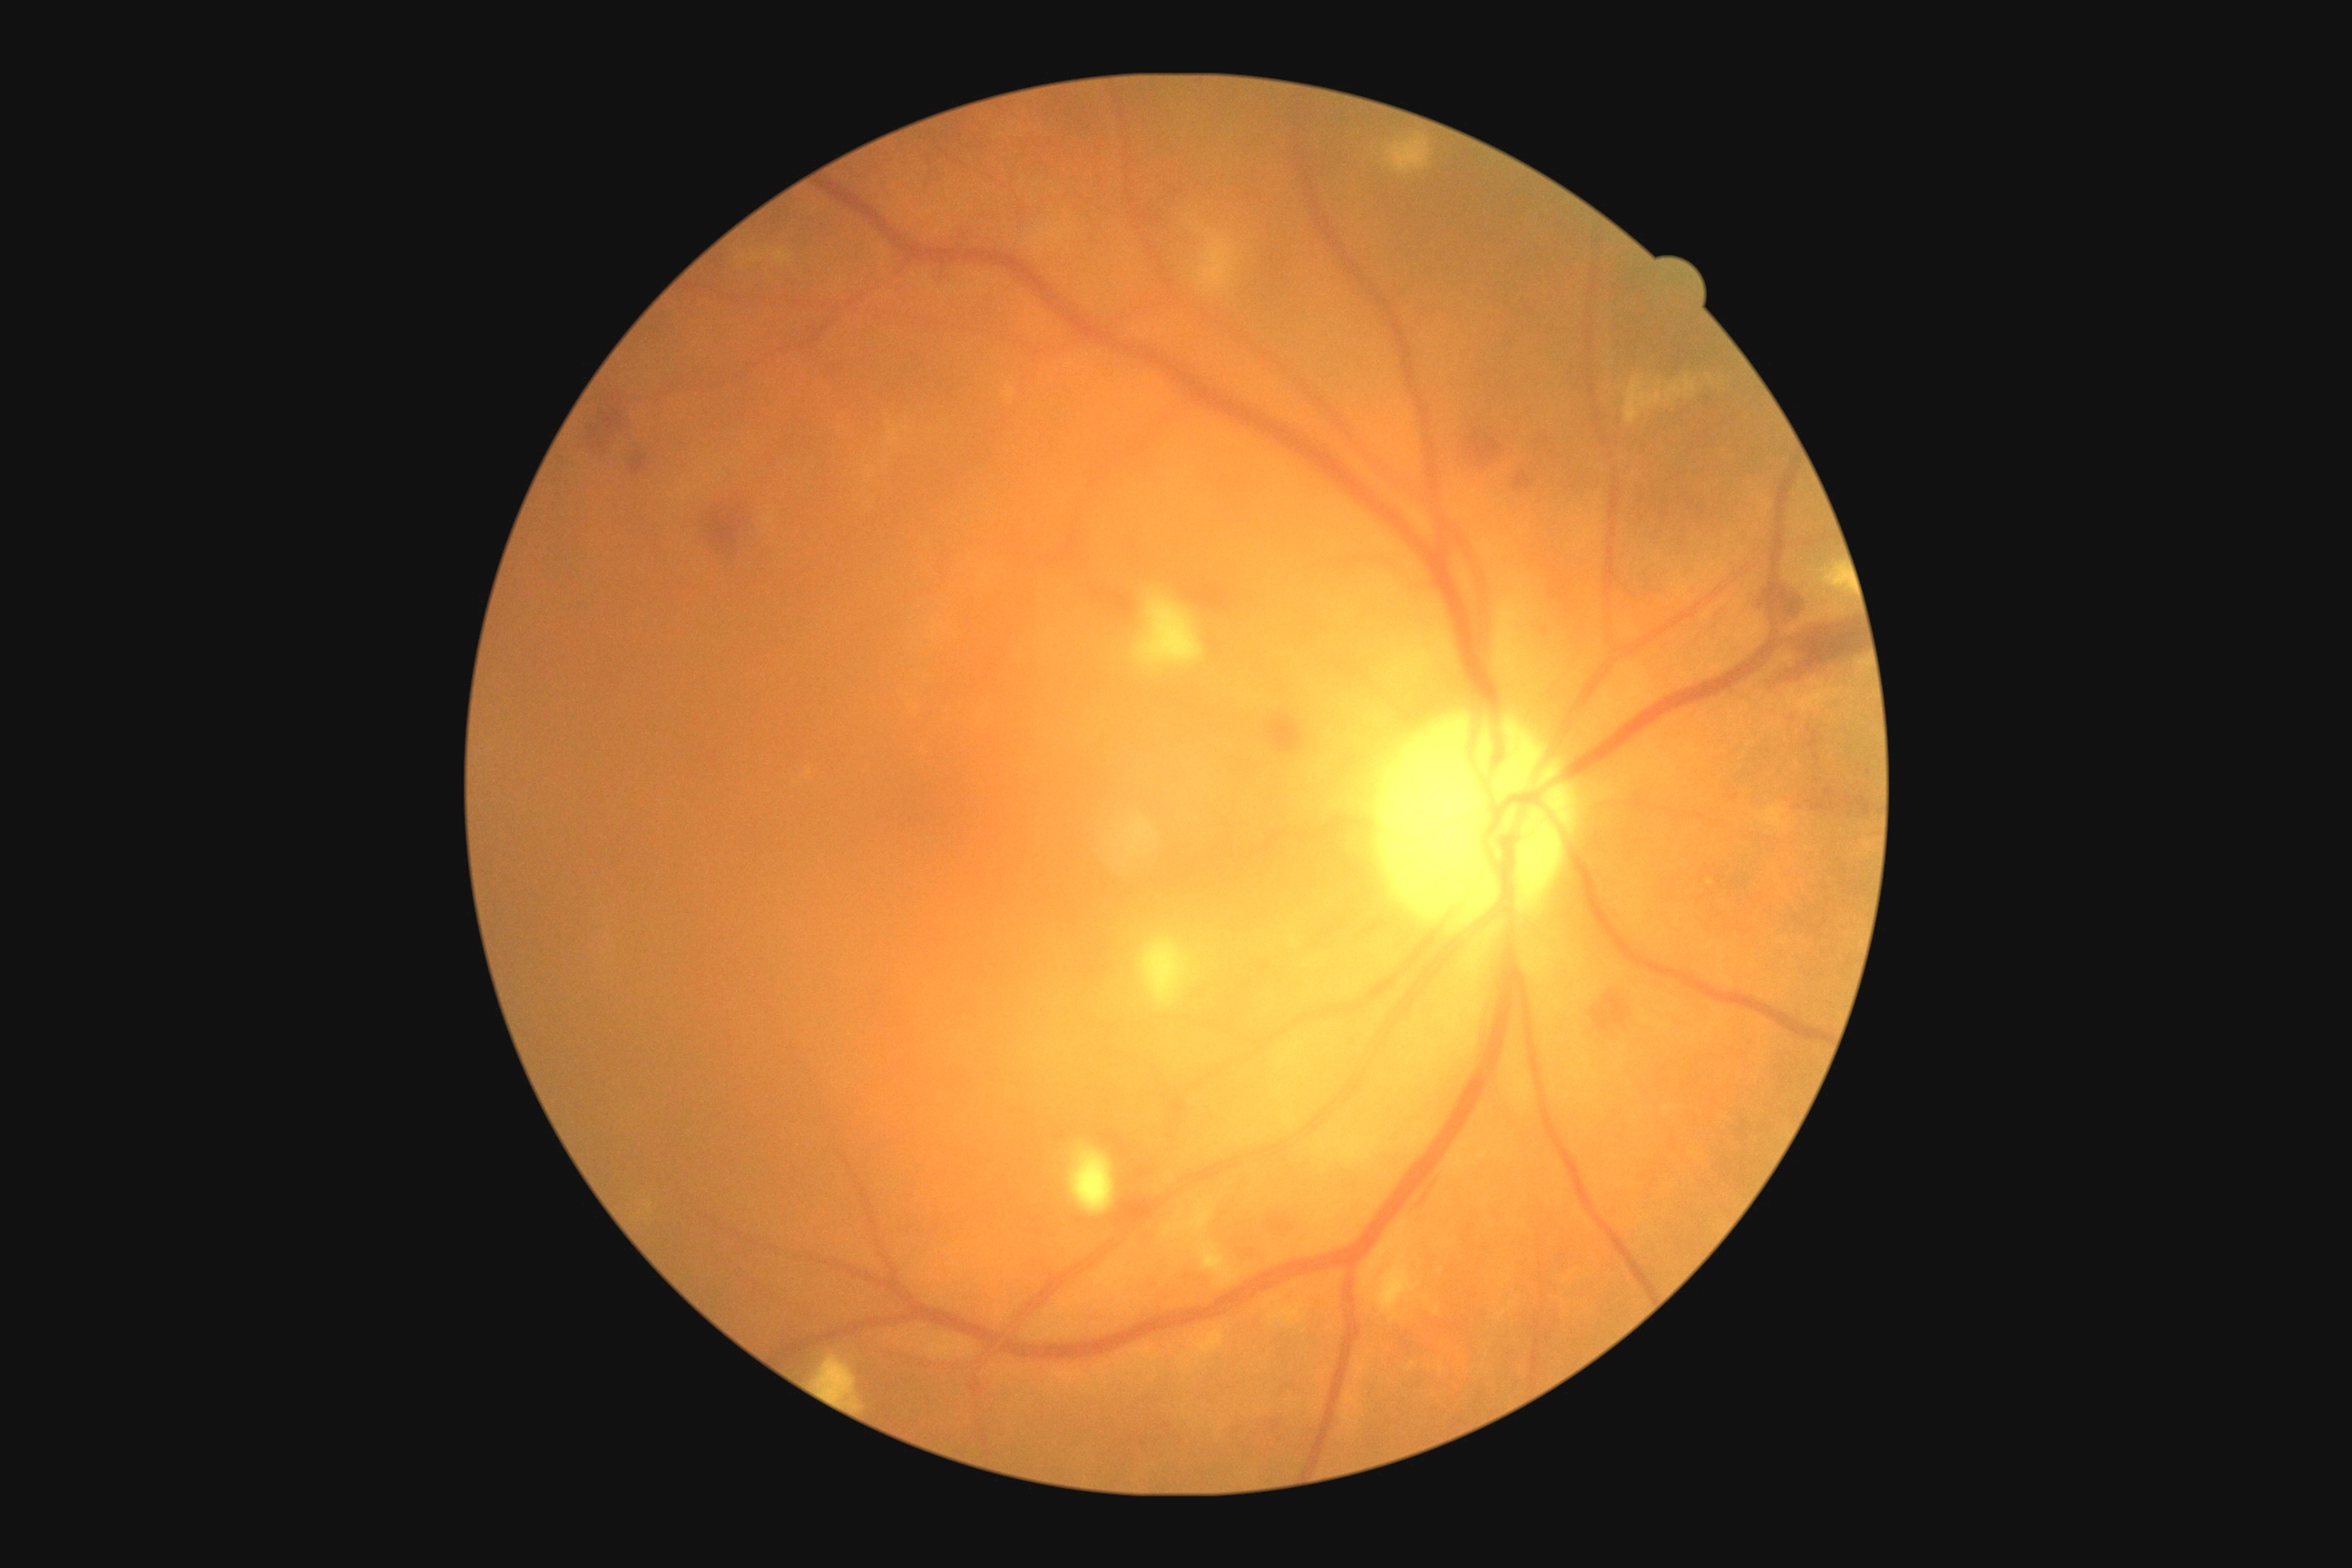
Diabetic retinopathy (DR) is grade 2 (moderate NPDR).